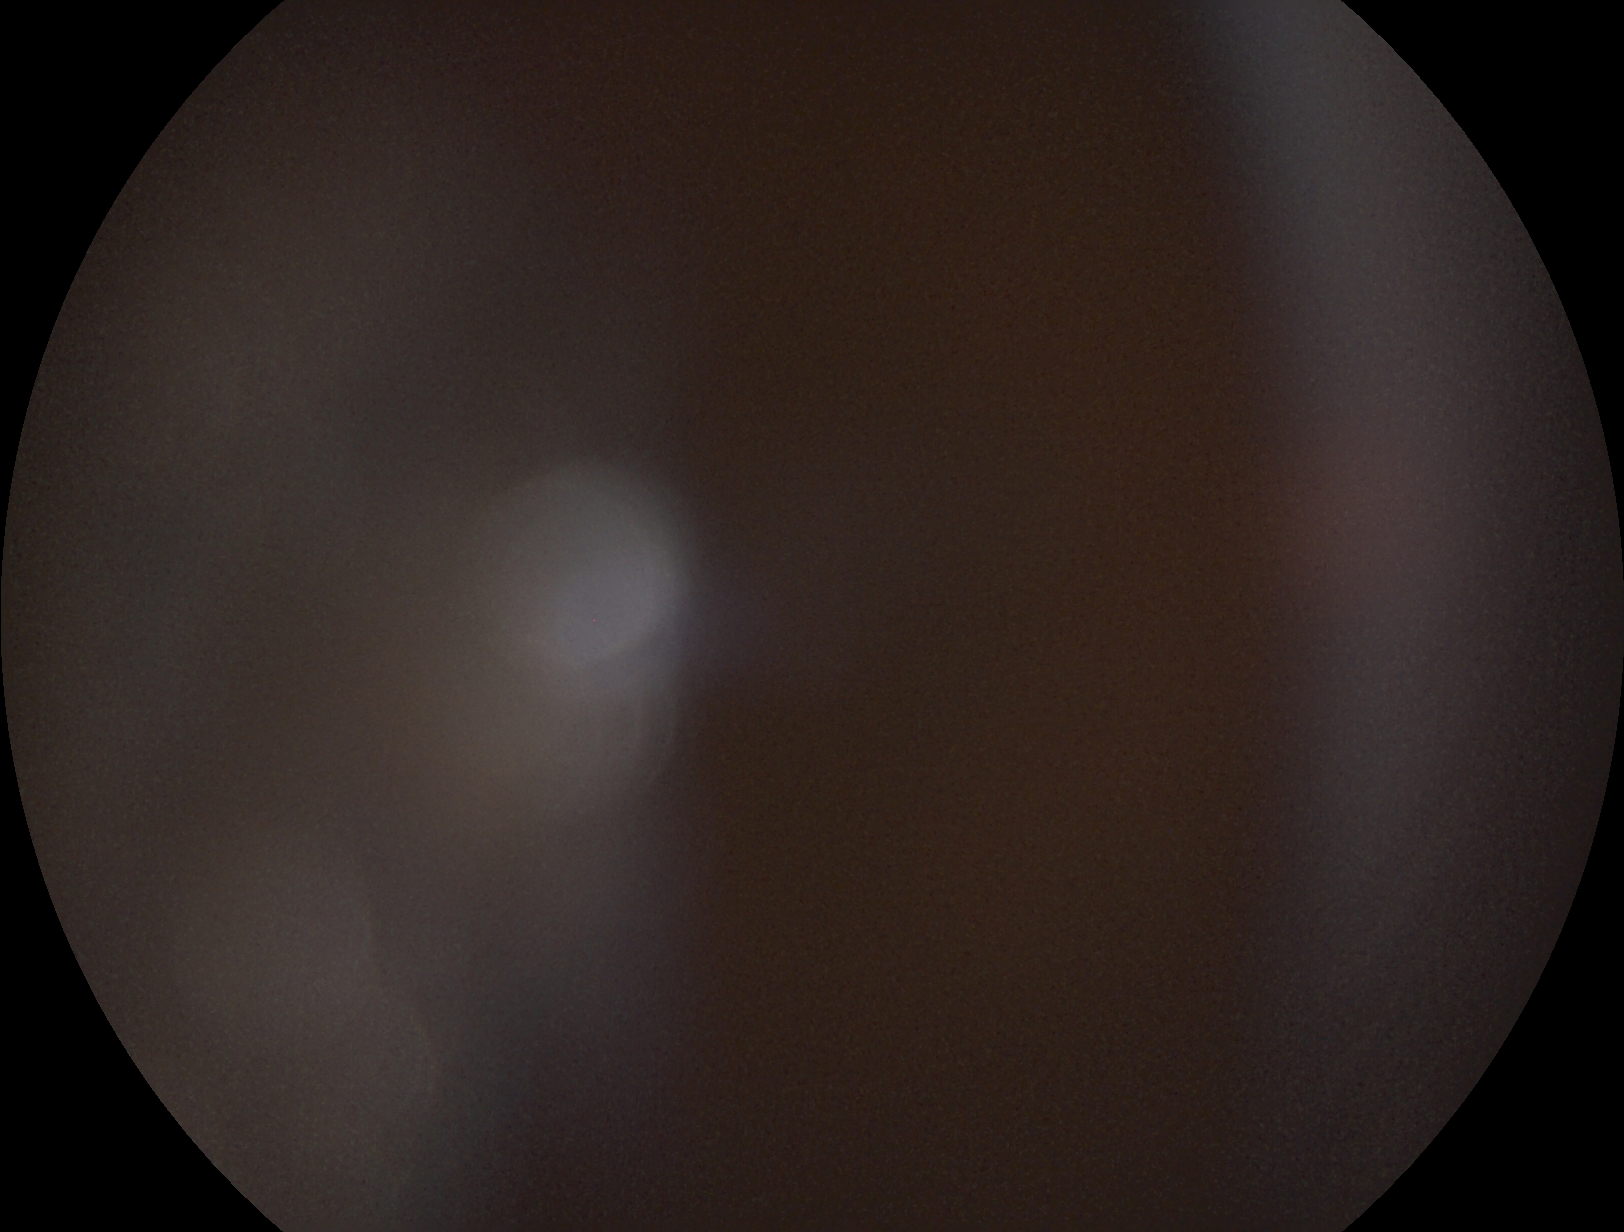
The image cannot be graded for diabetic retinopathy. DR severity: ungradable due to poor image quality.